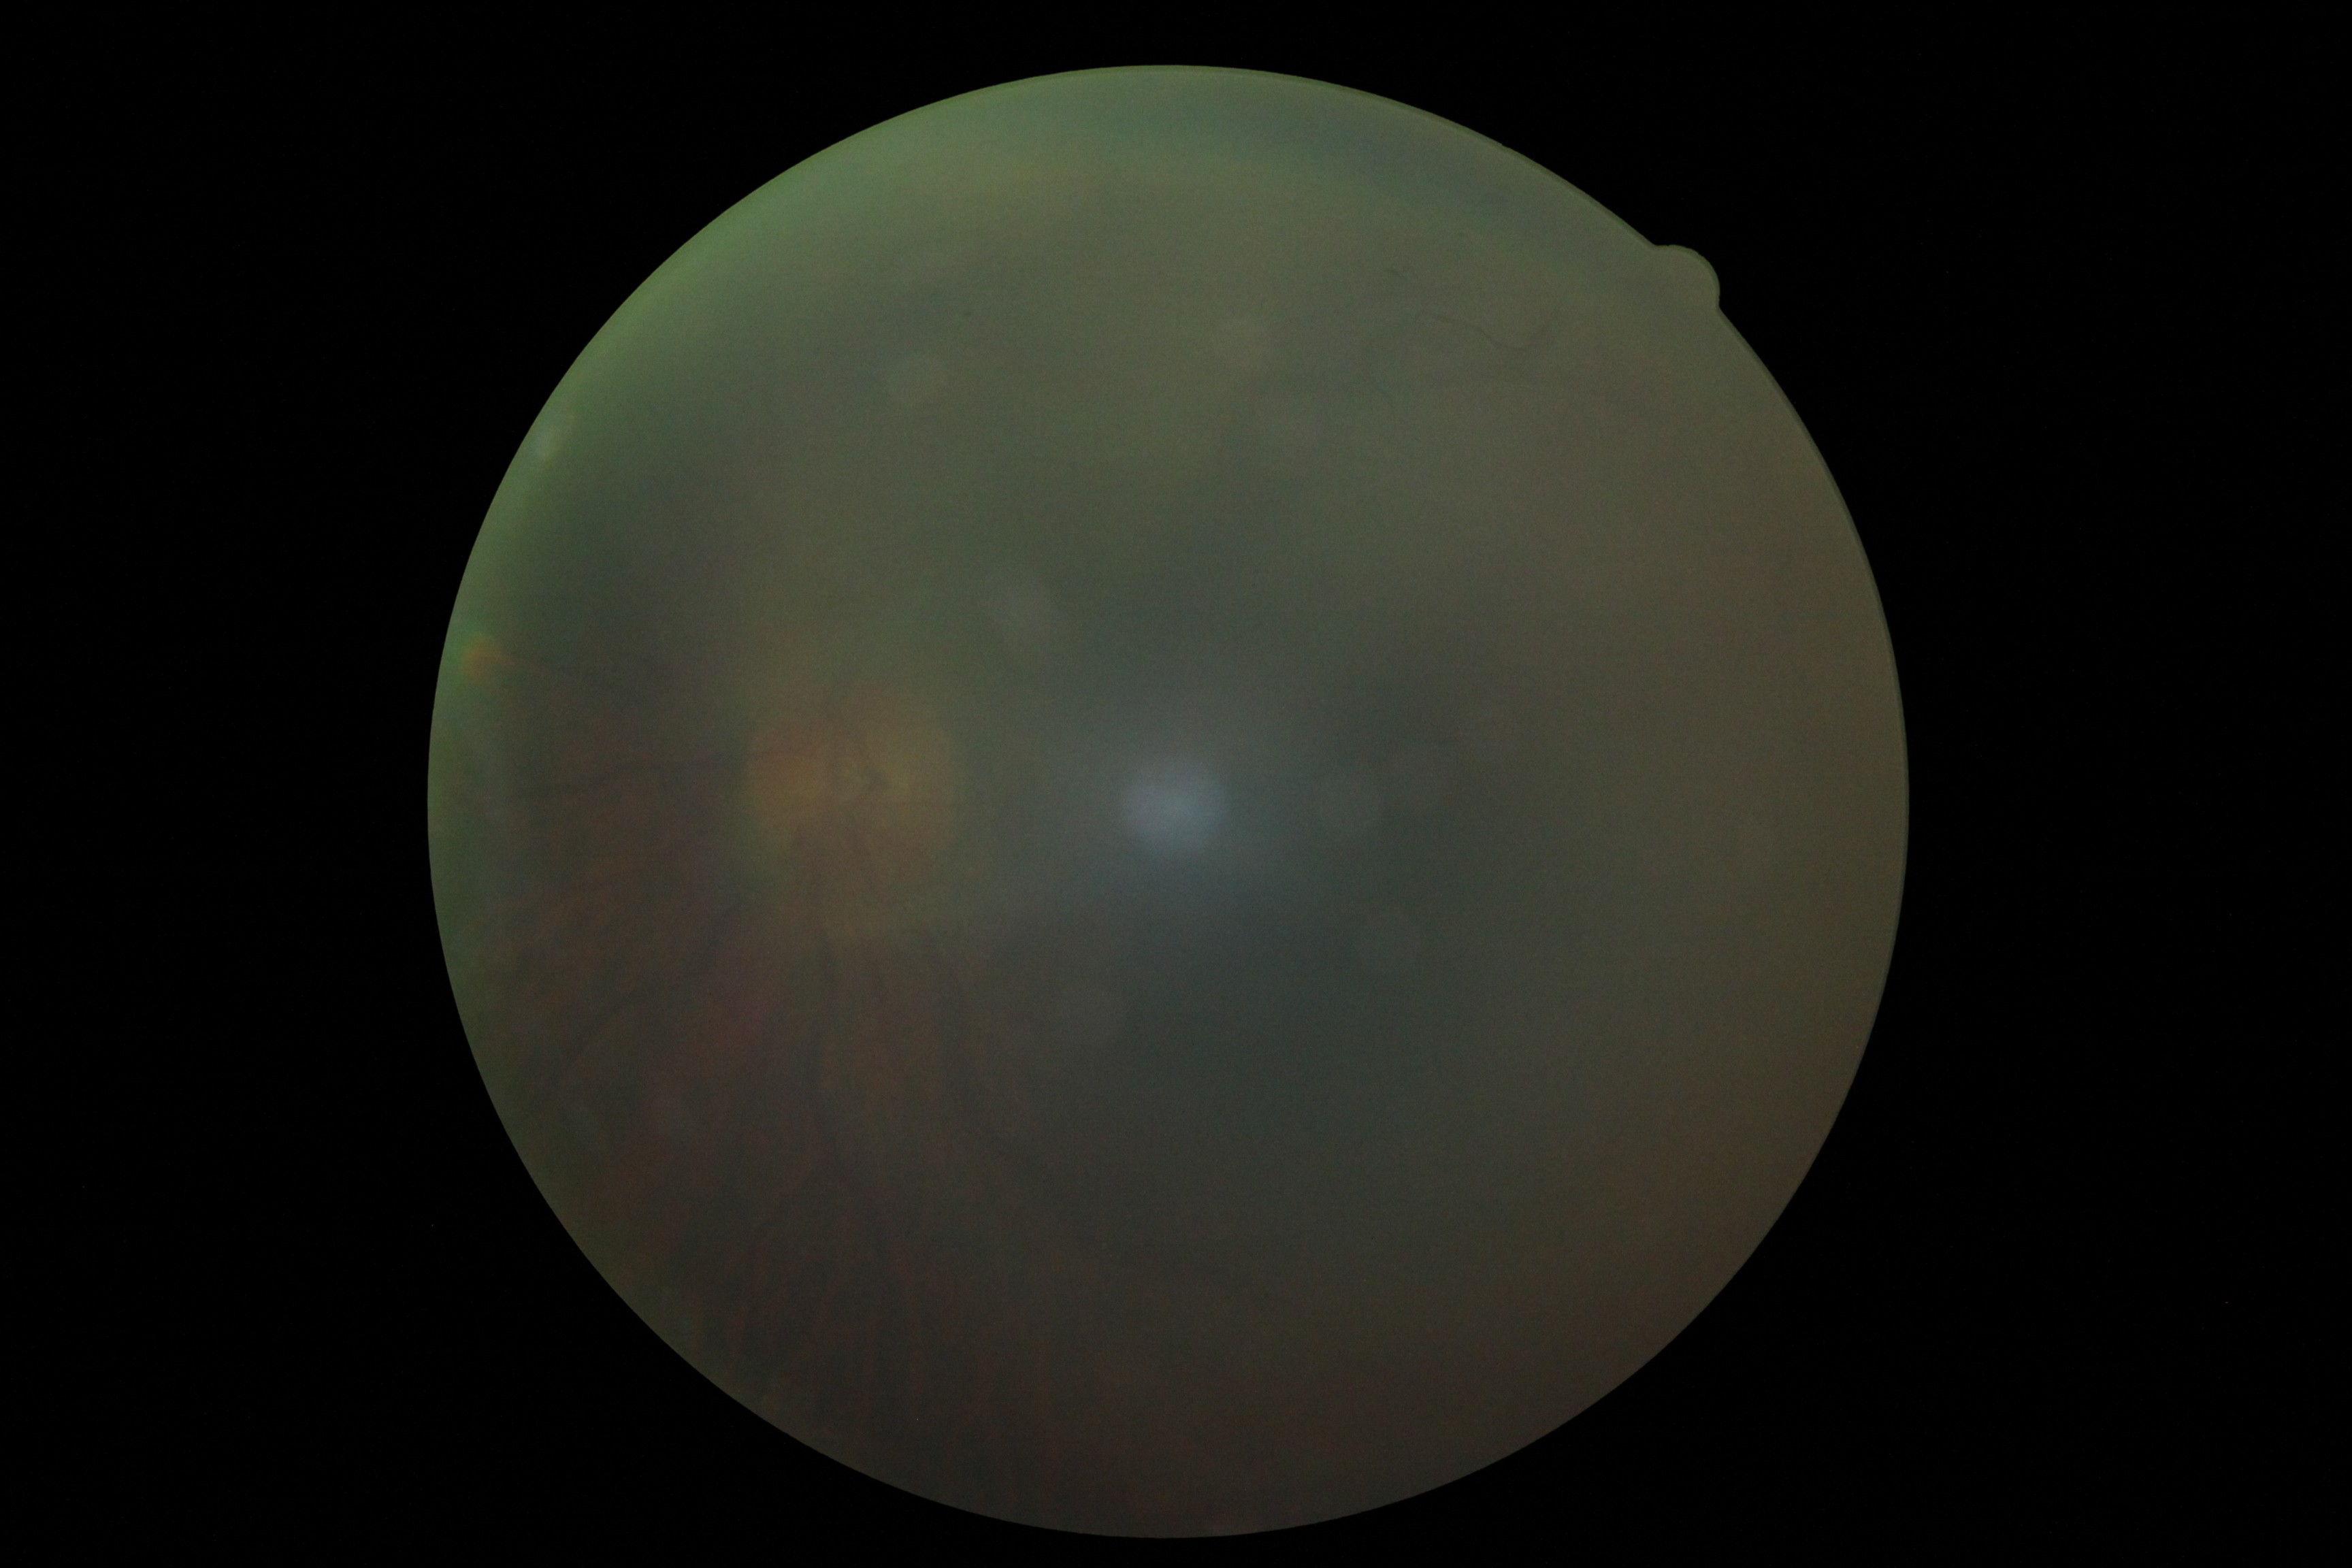
Image quality is insufficient for diabetic retinopathy assessment. DR grade: ungradable due to poor image quality.